1932 by 1932 pixels.
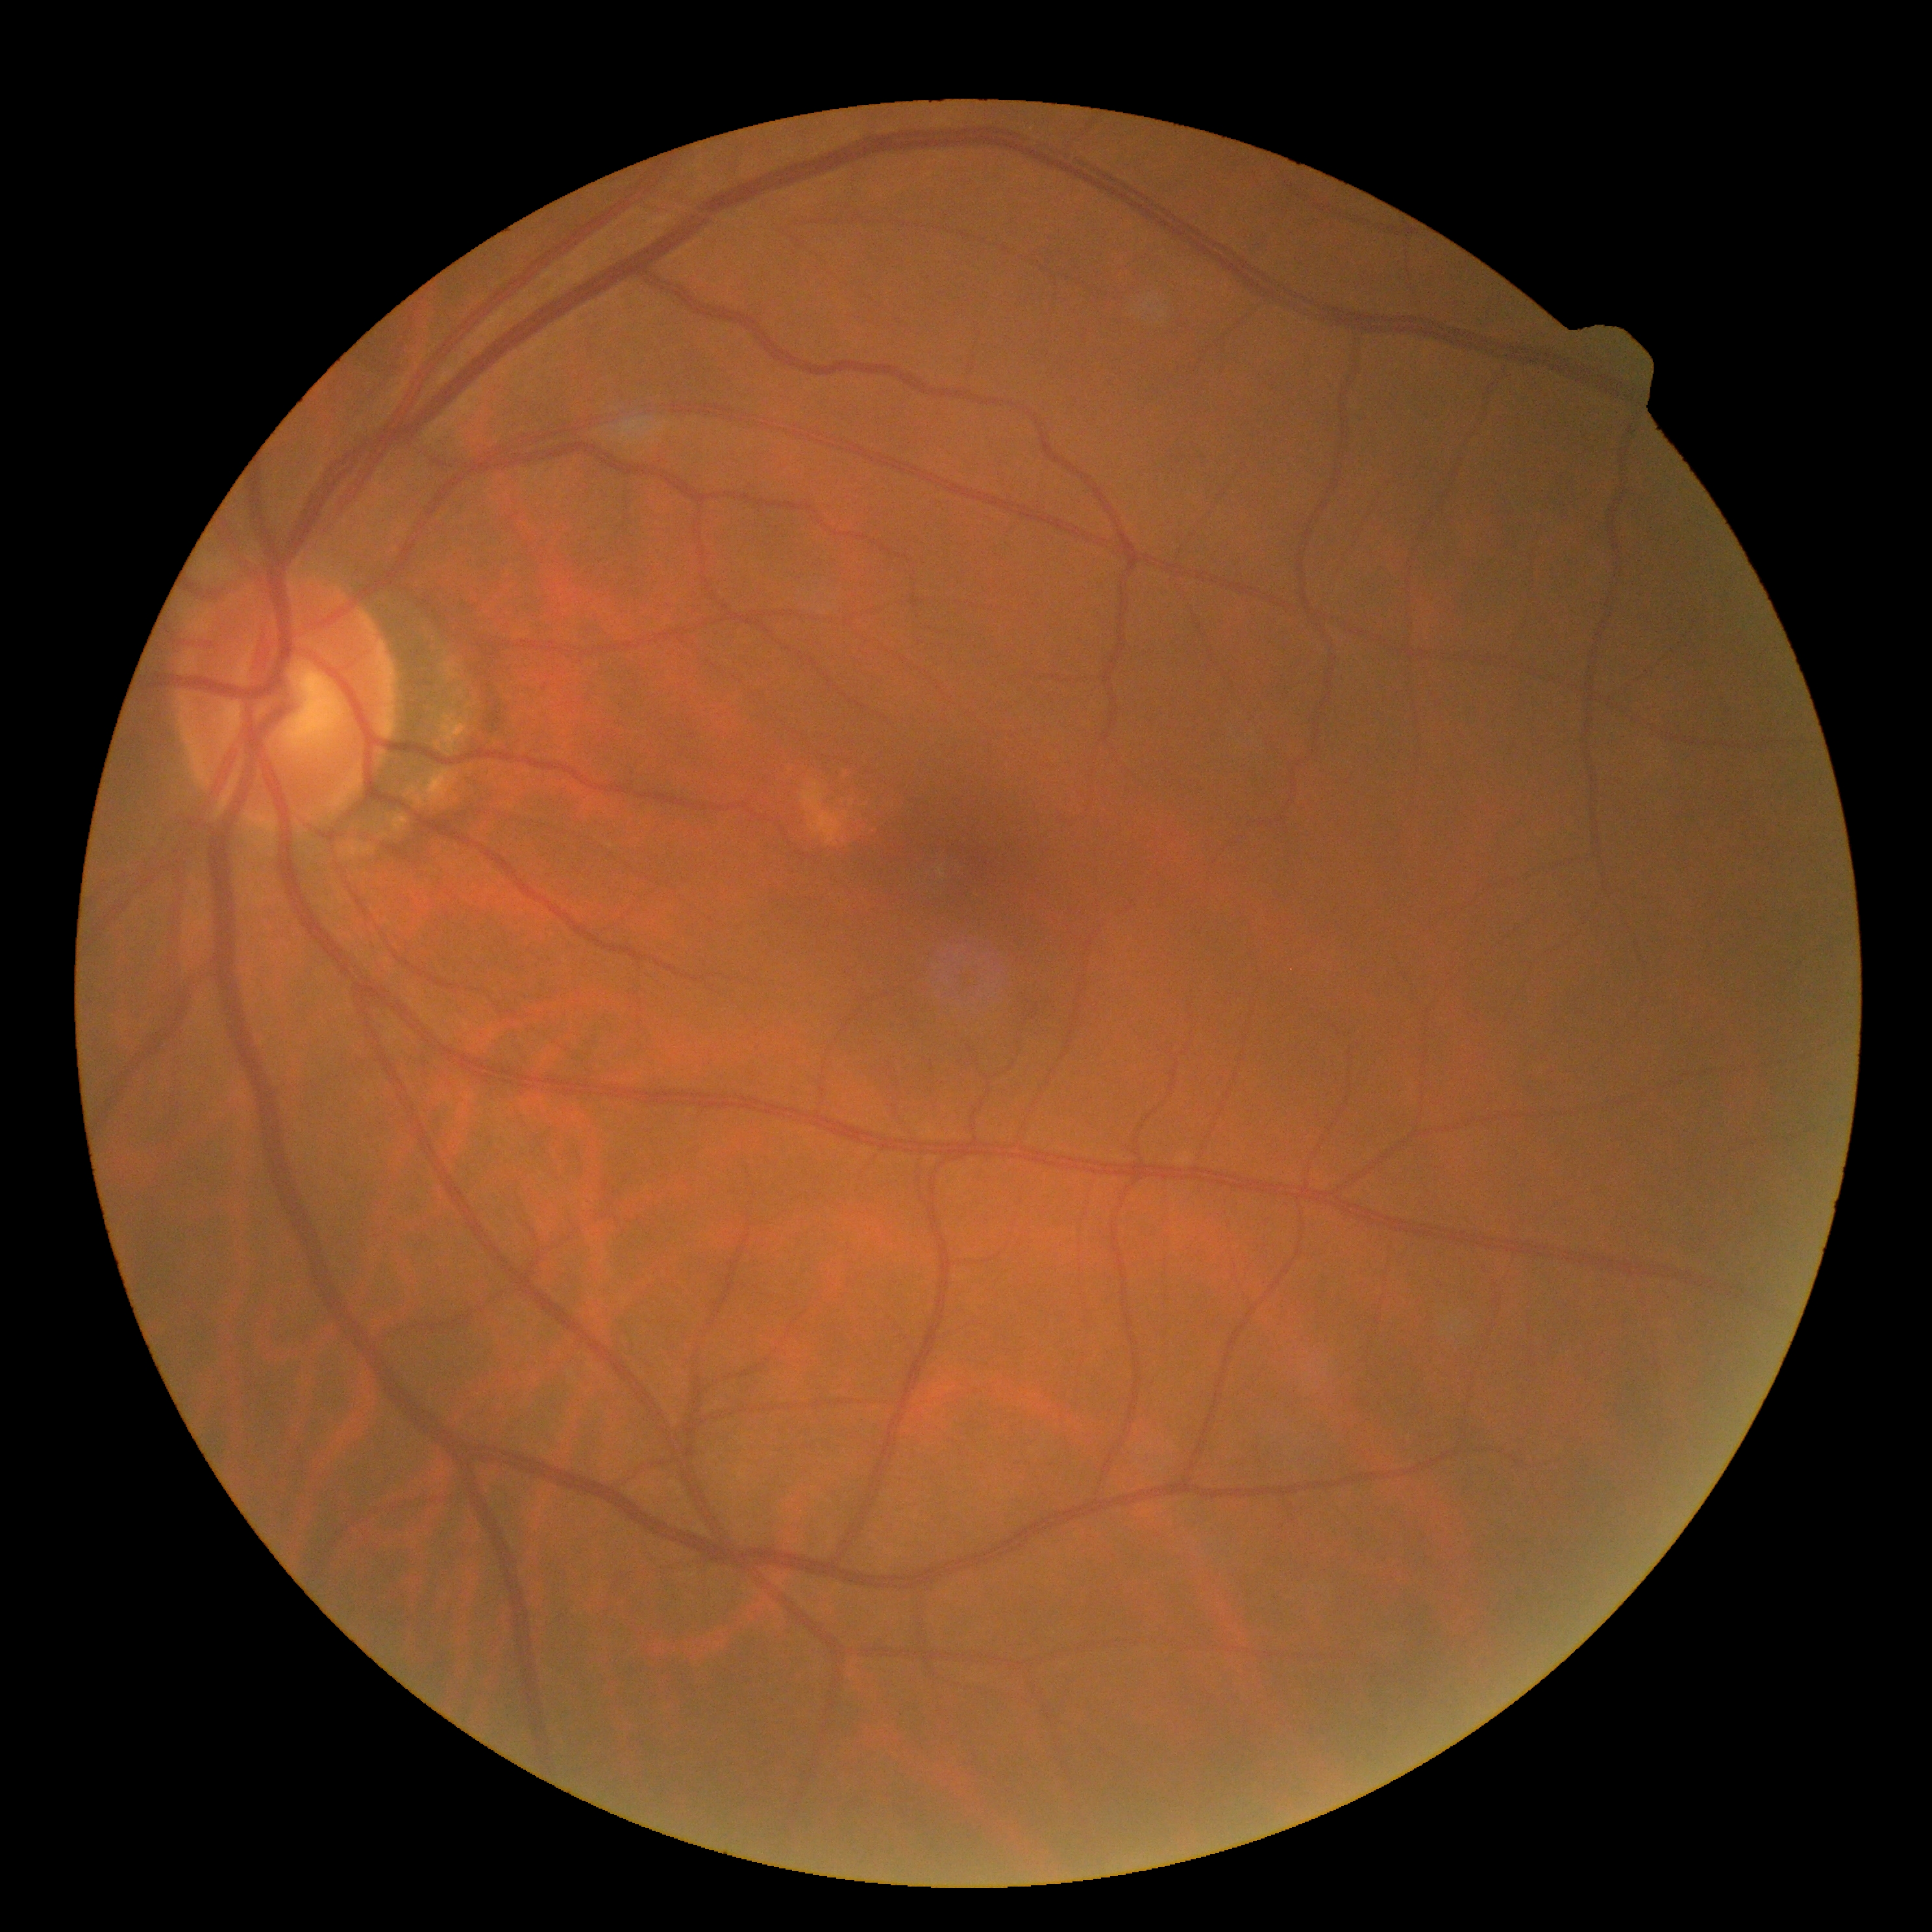
DR grade is no apparent retinopathy (0) — no visible signs of diabetic retinopathy.